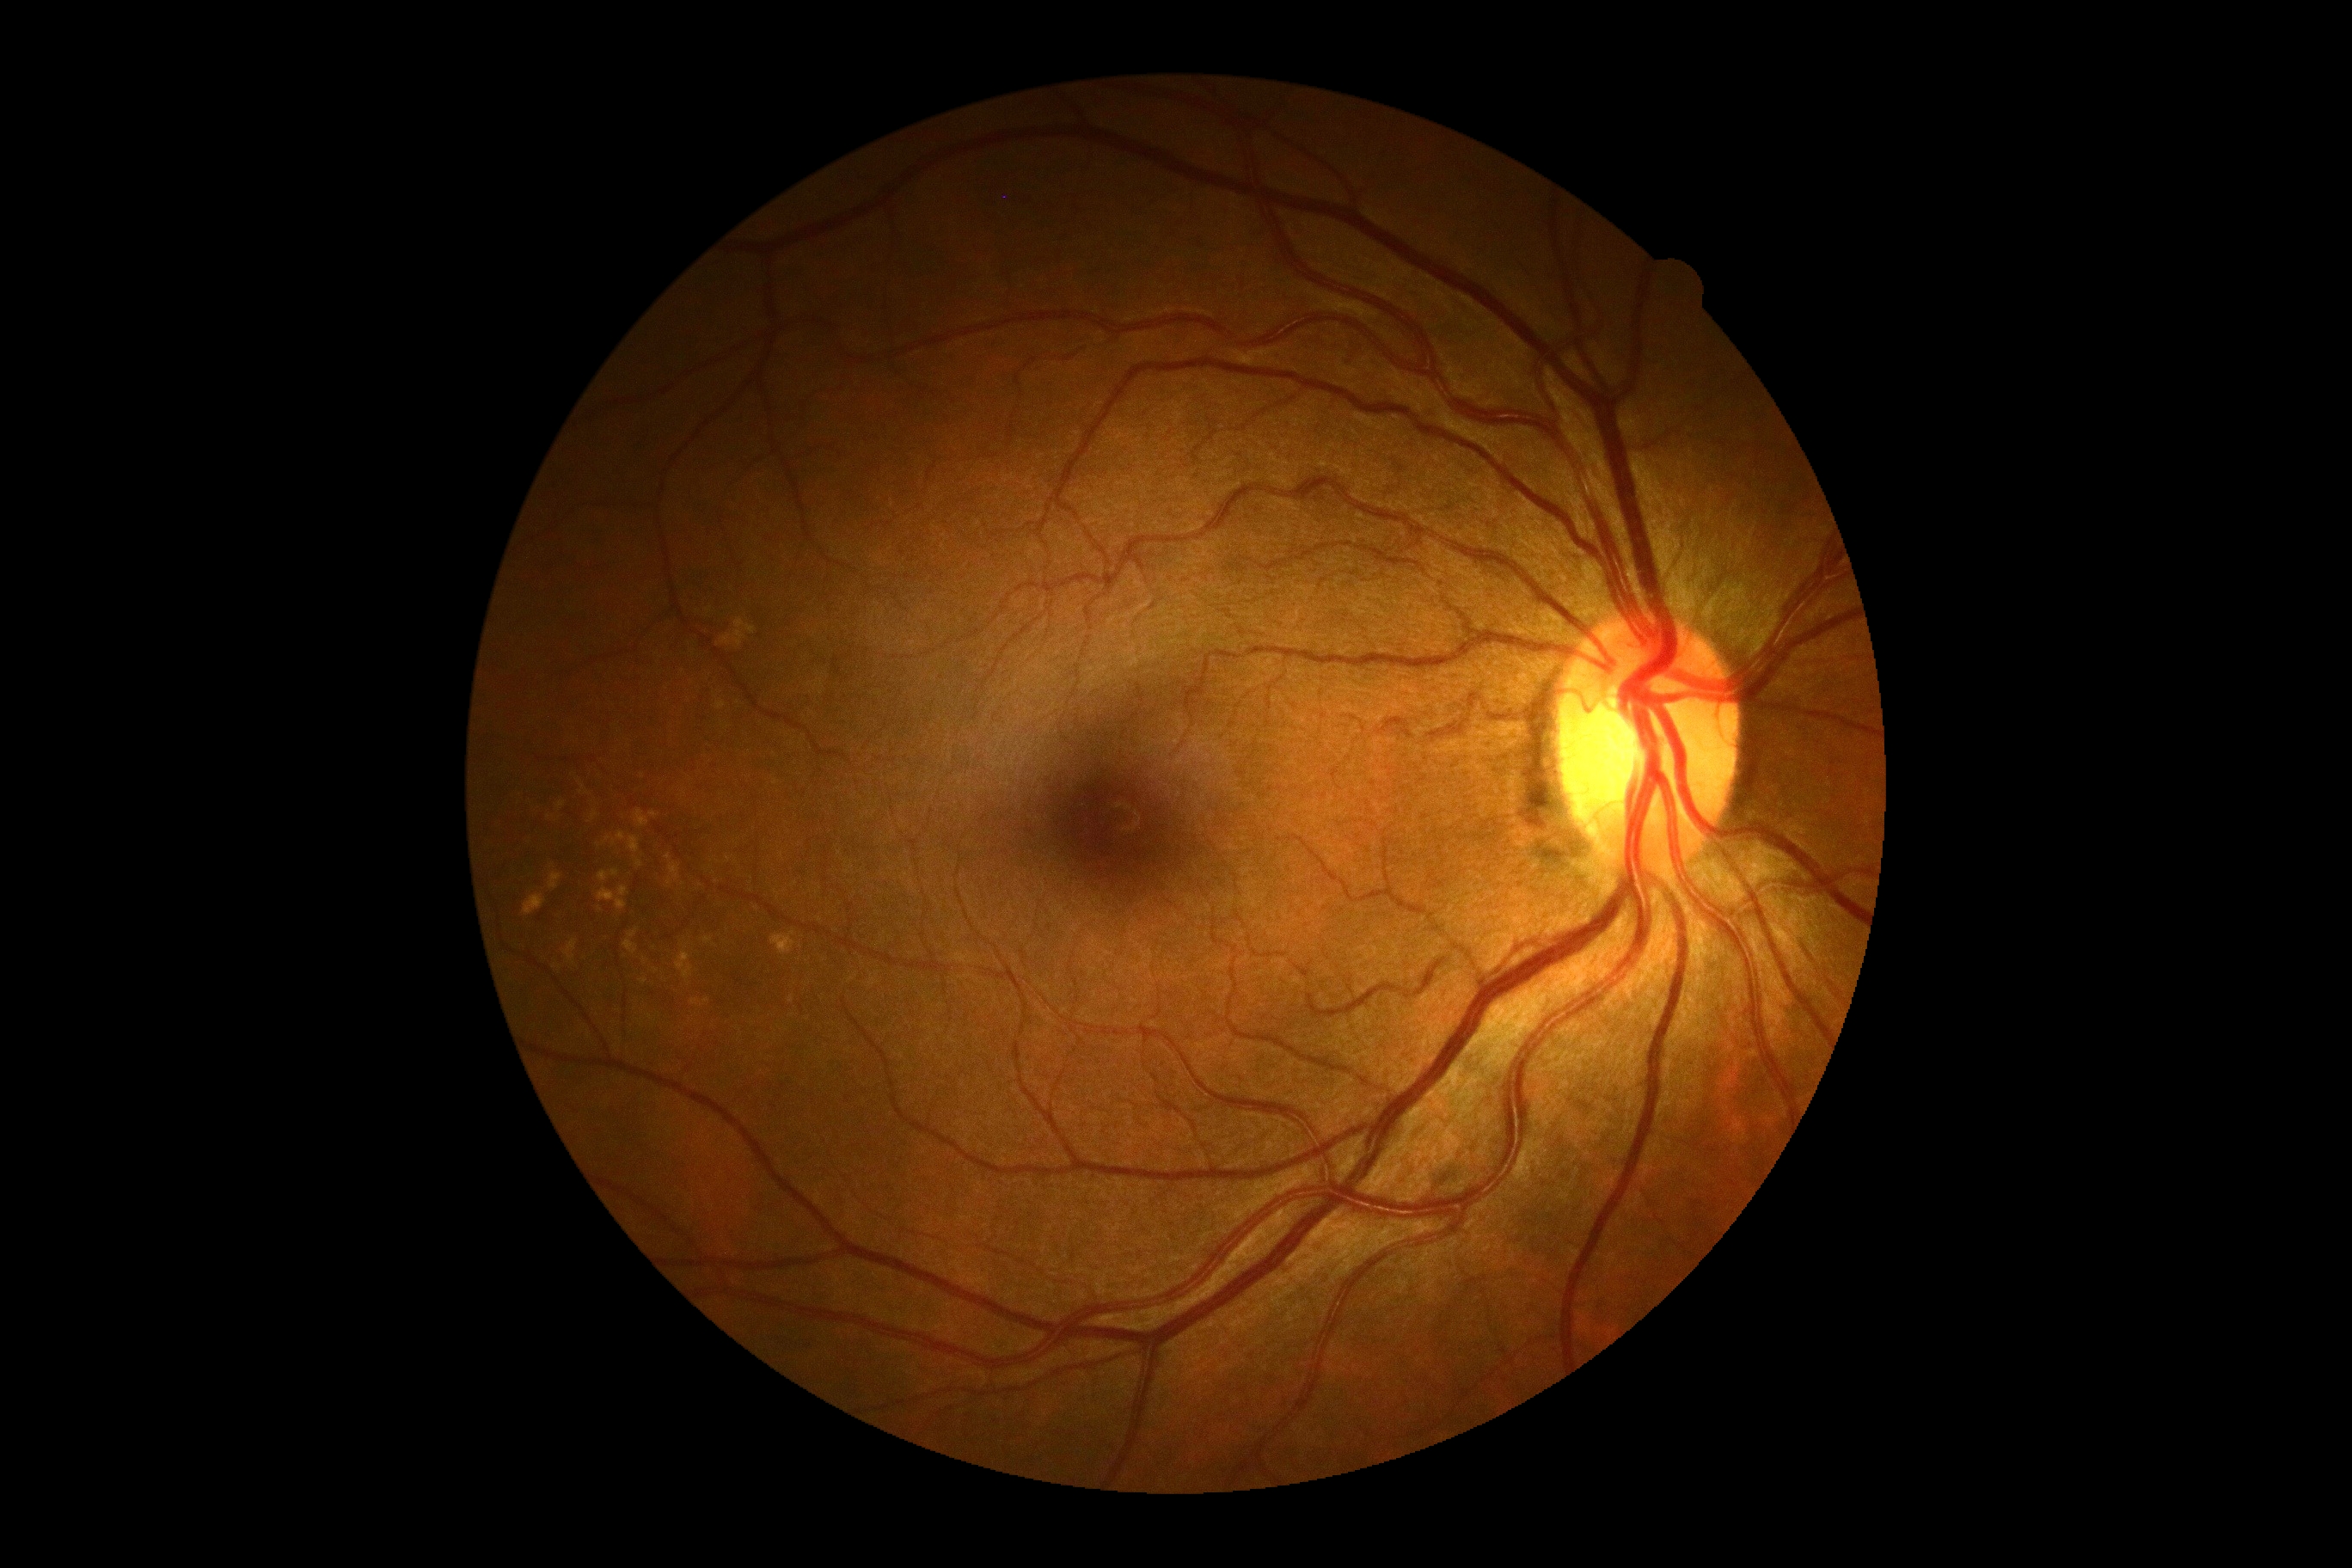 DR severity: grade 0.